Natus RetCam Envision, 130° FOV. Wide-field fundus image from infant ROP screening.
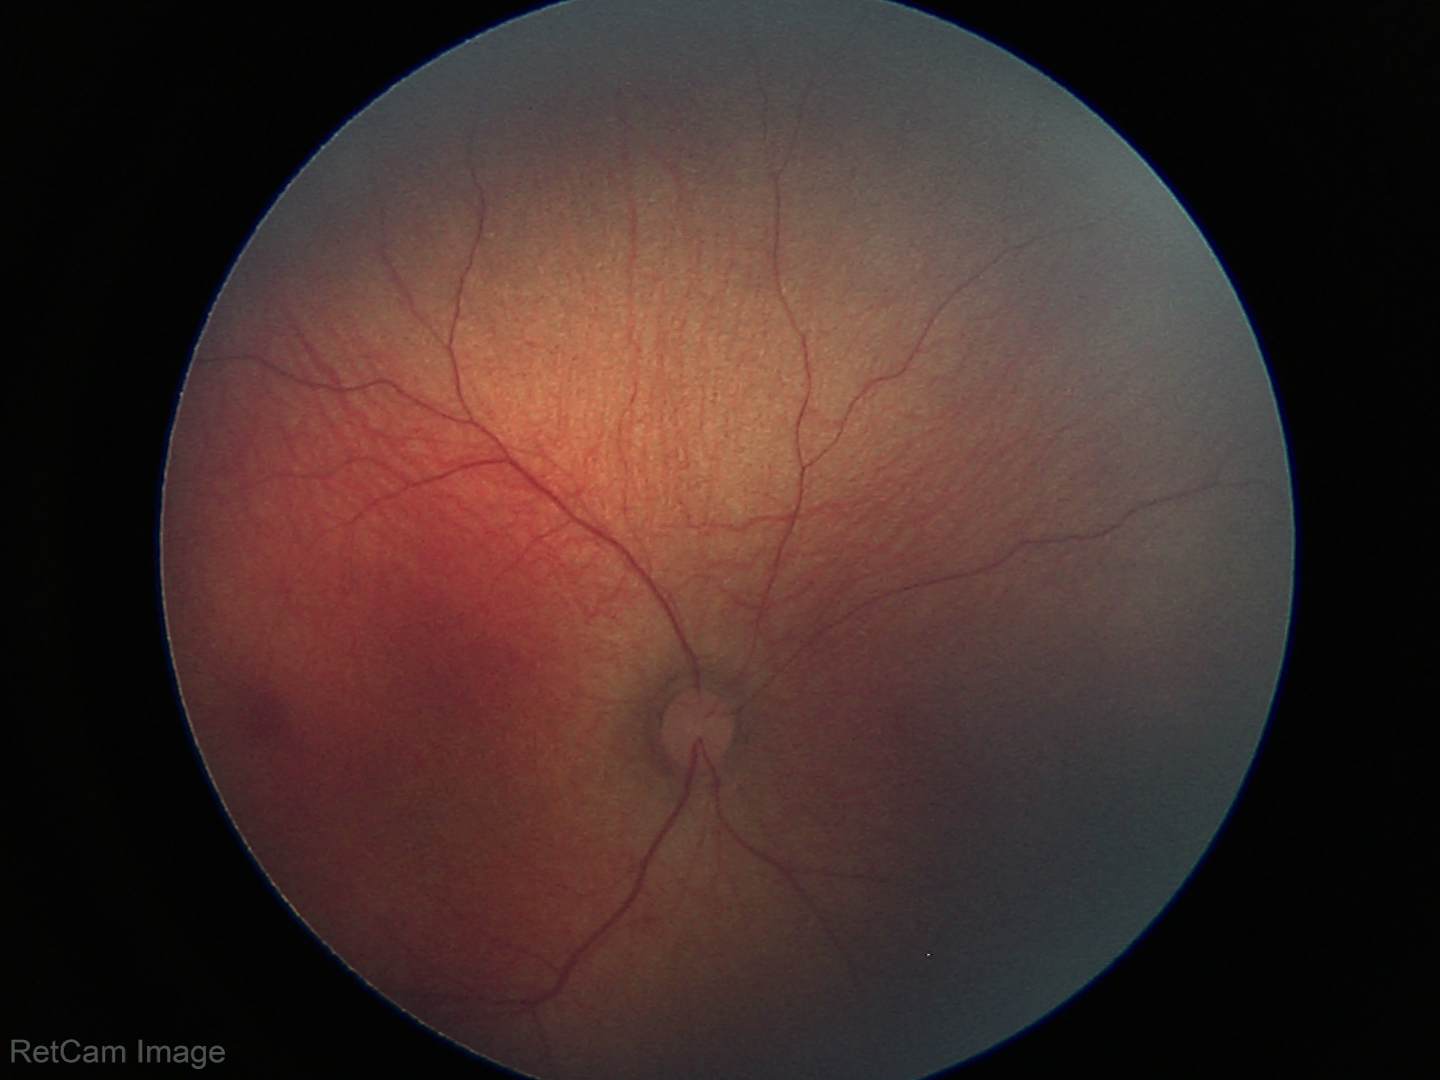 Physiological retinal appearance for postconceptual age.